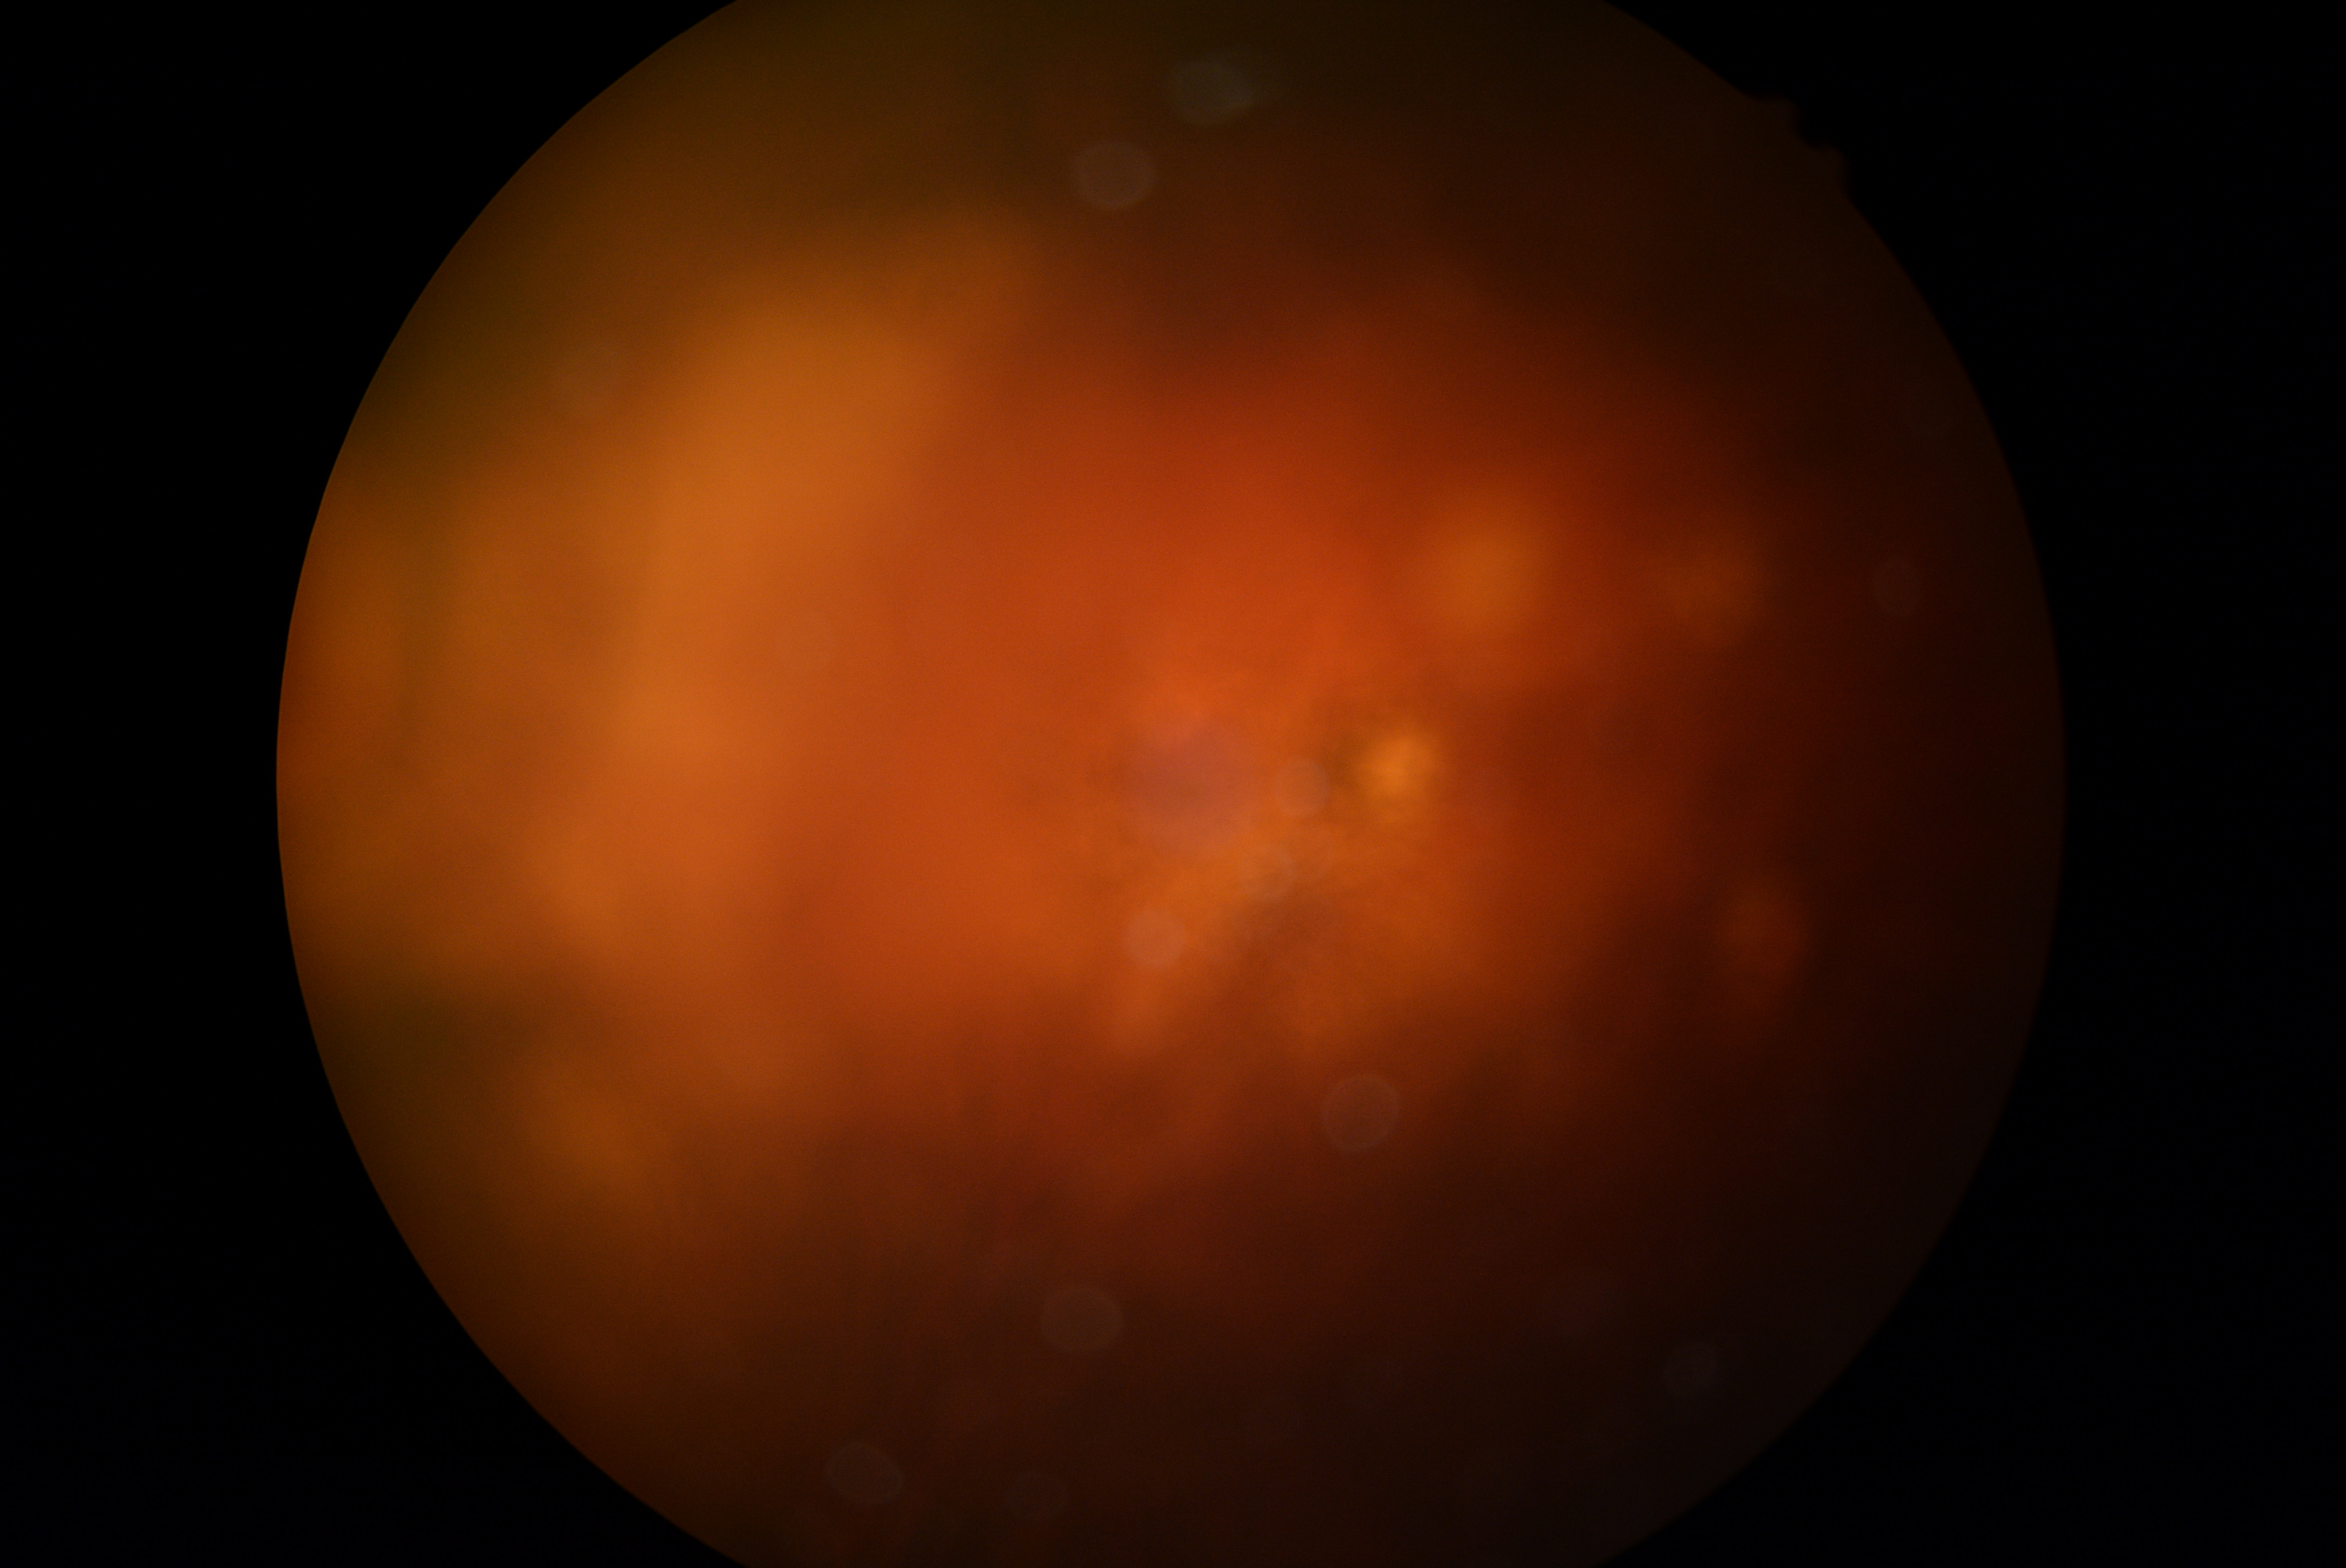

Quality too poor to assess for DR.
DR: ungradable due to poor image quality.